2352x1568: 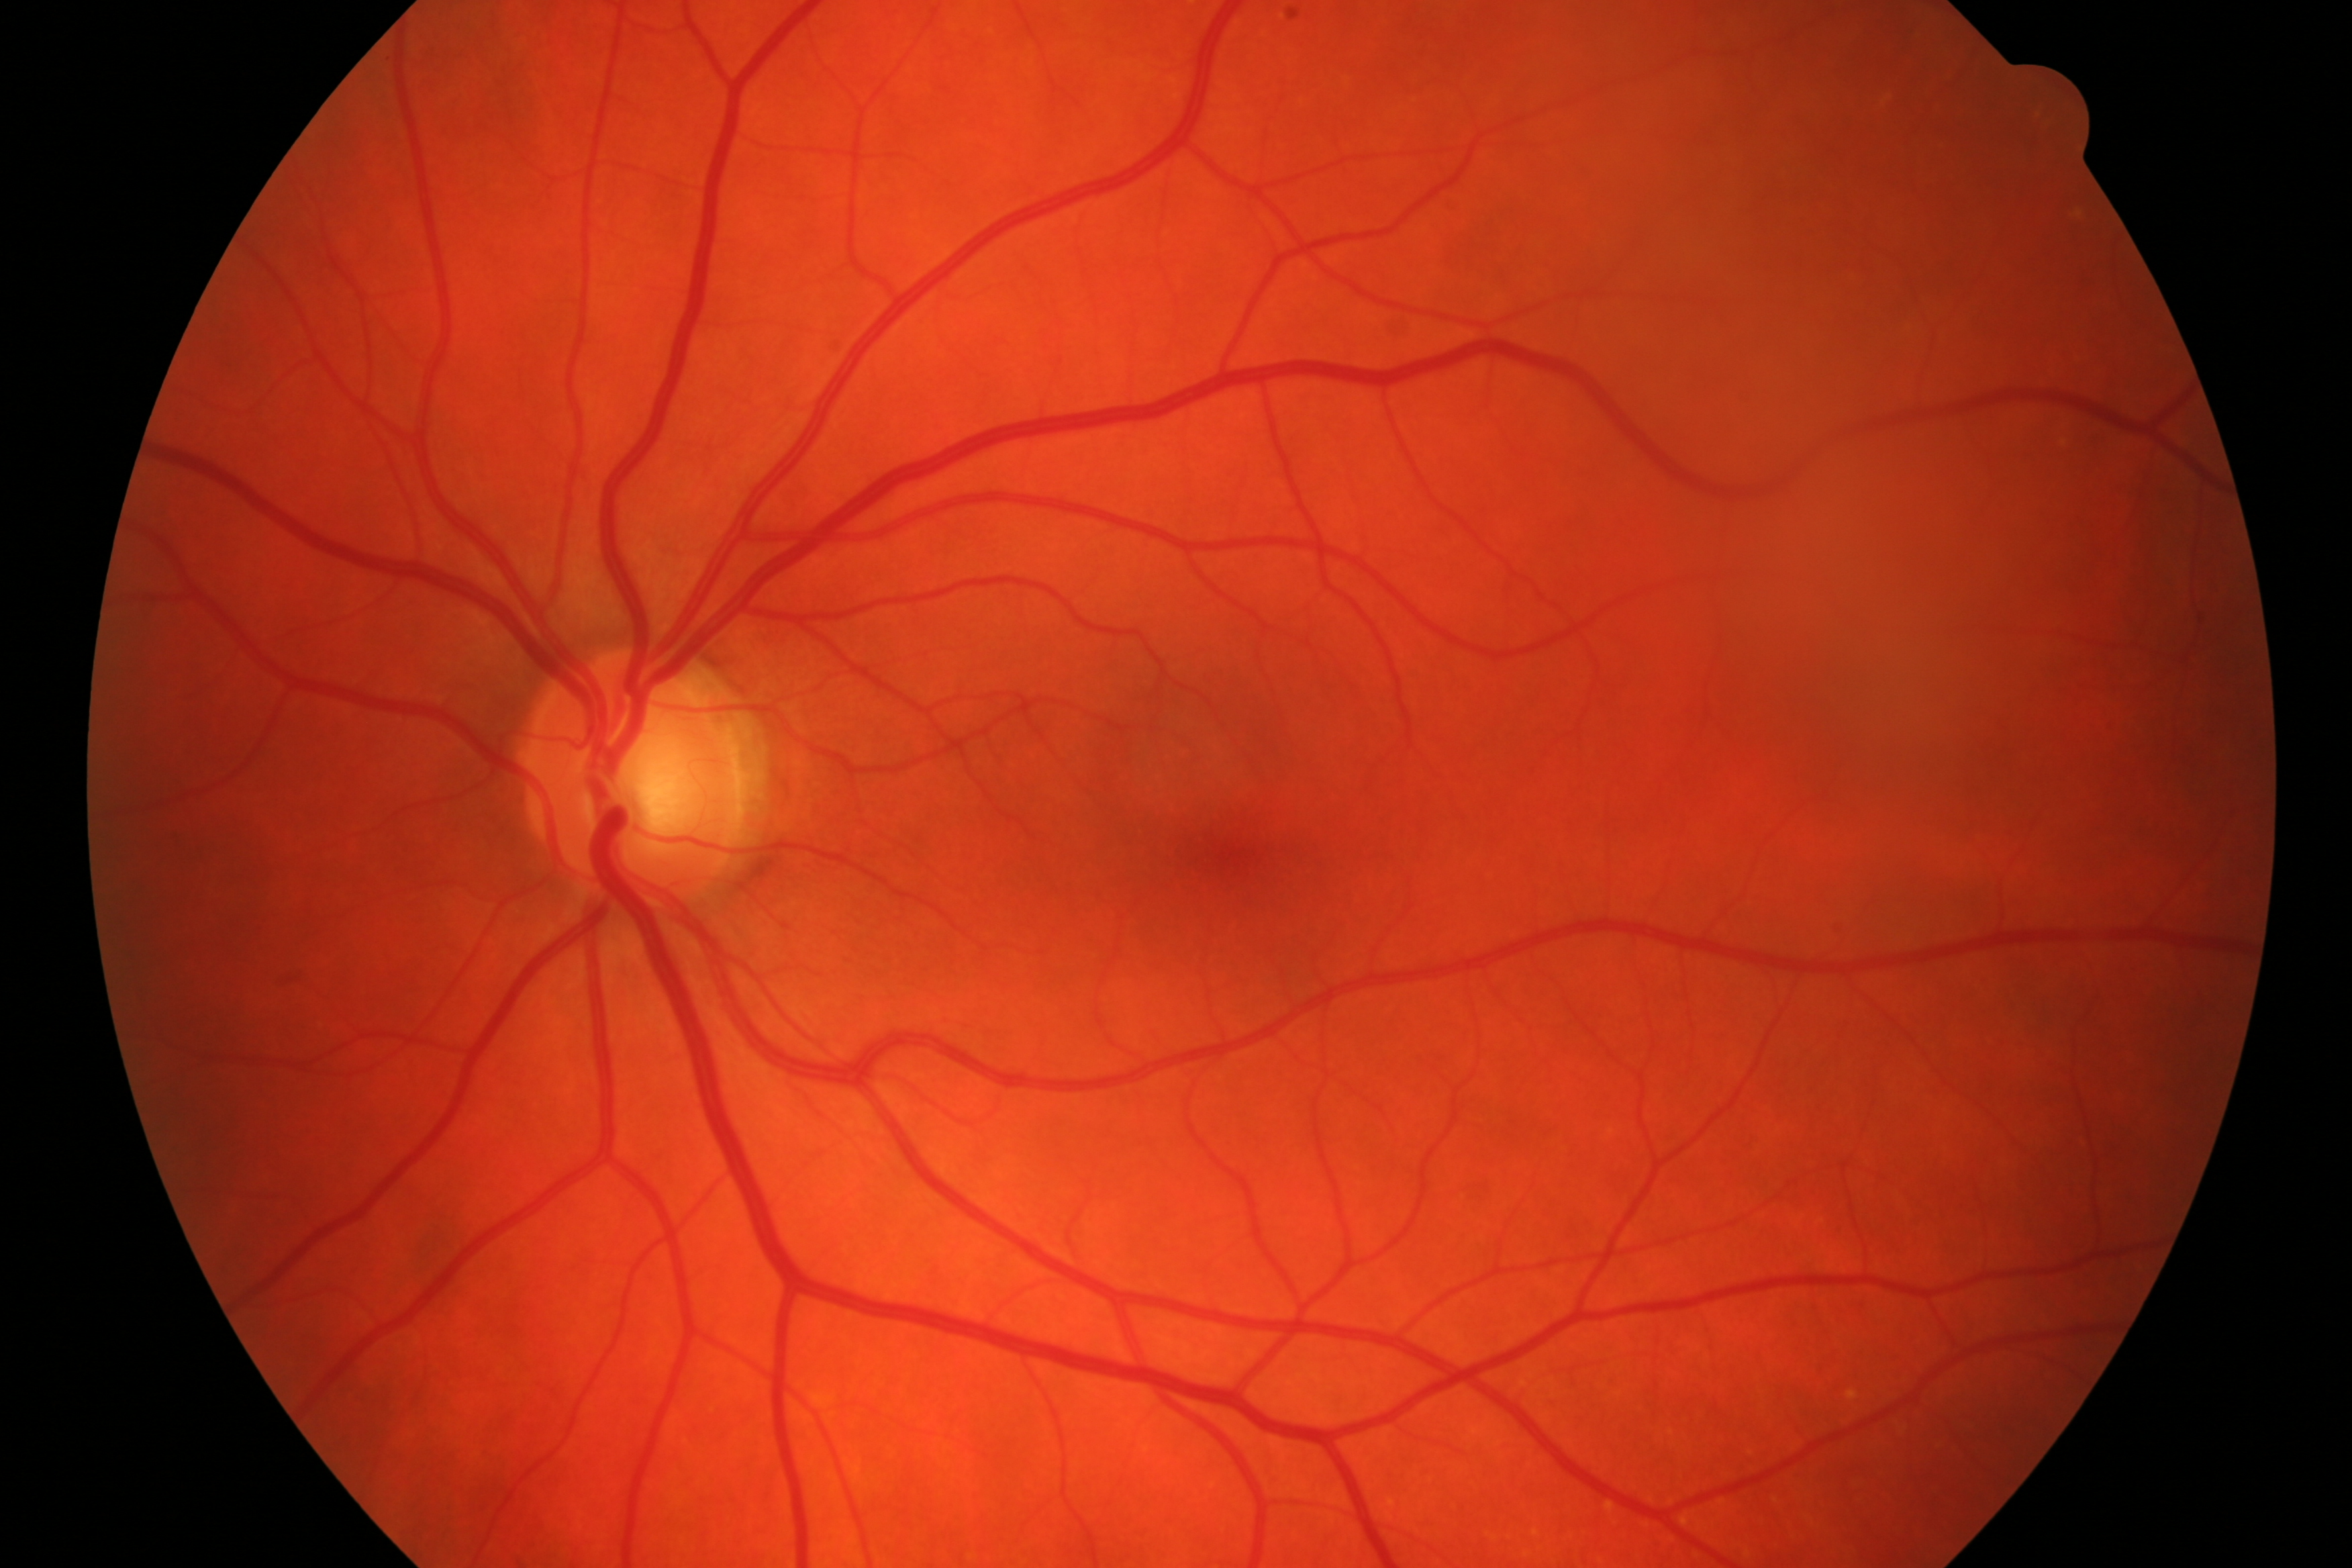 Assessment: glaucomatous optic neuropathy.